848x848px; nonmydriatic: 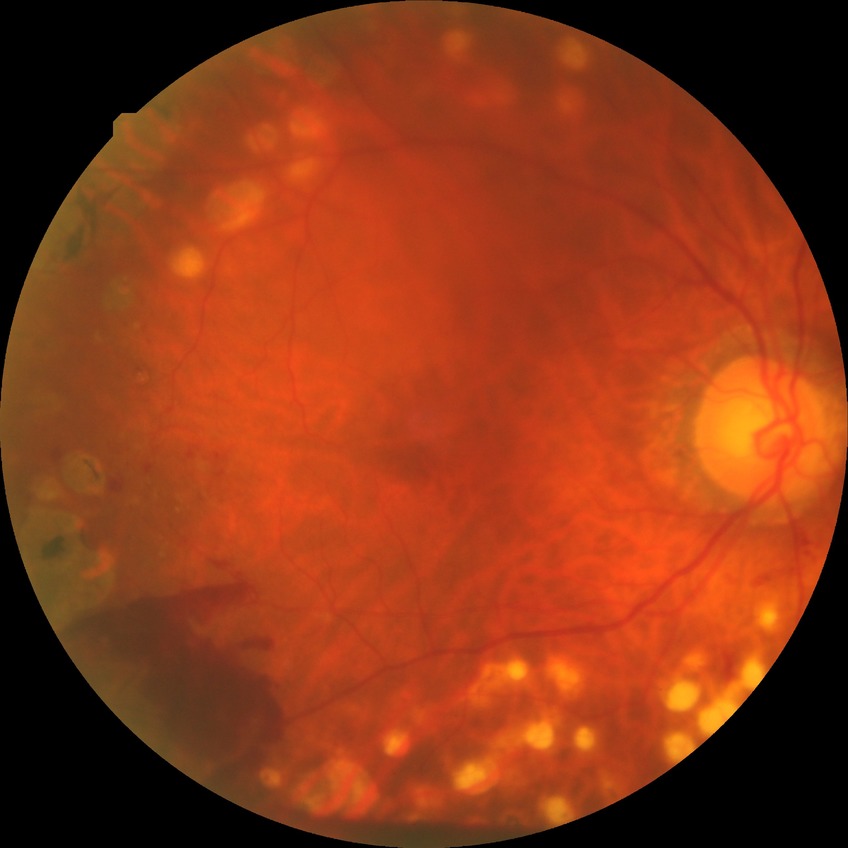 diabetic retinopathy (DR): proliferative diabetic retinopathy (PDR)